Image size 2352x1568
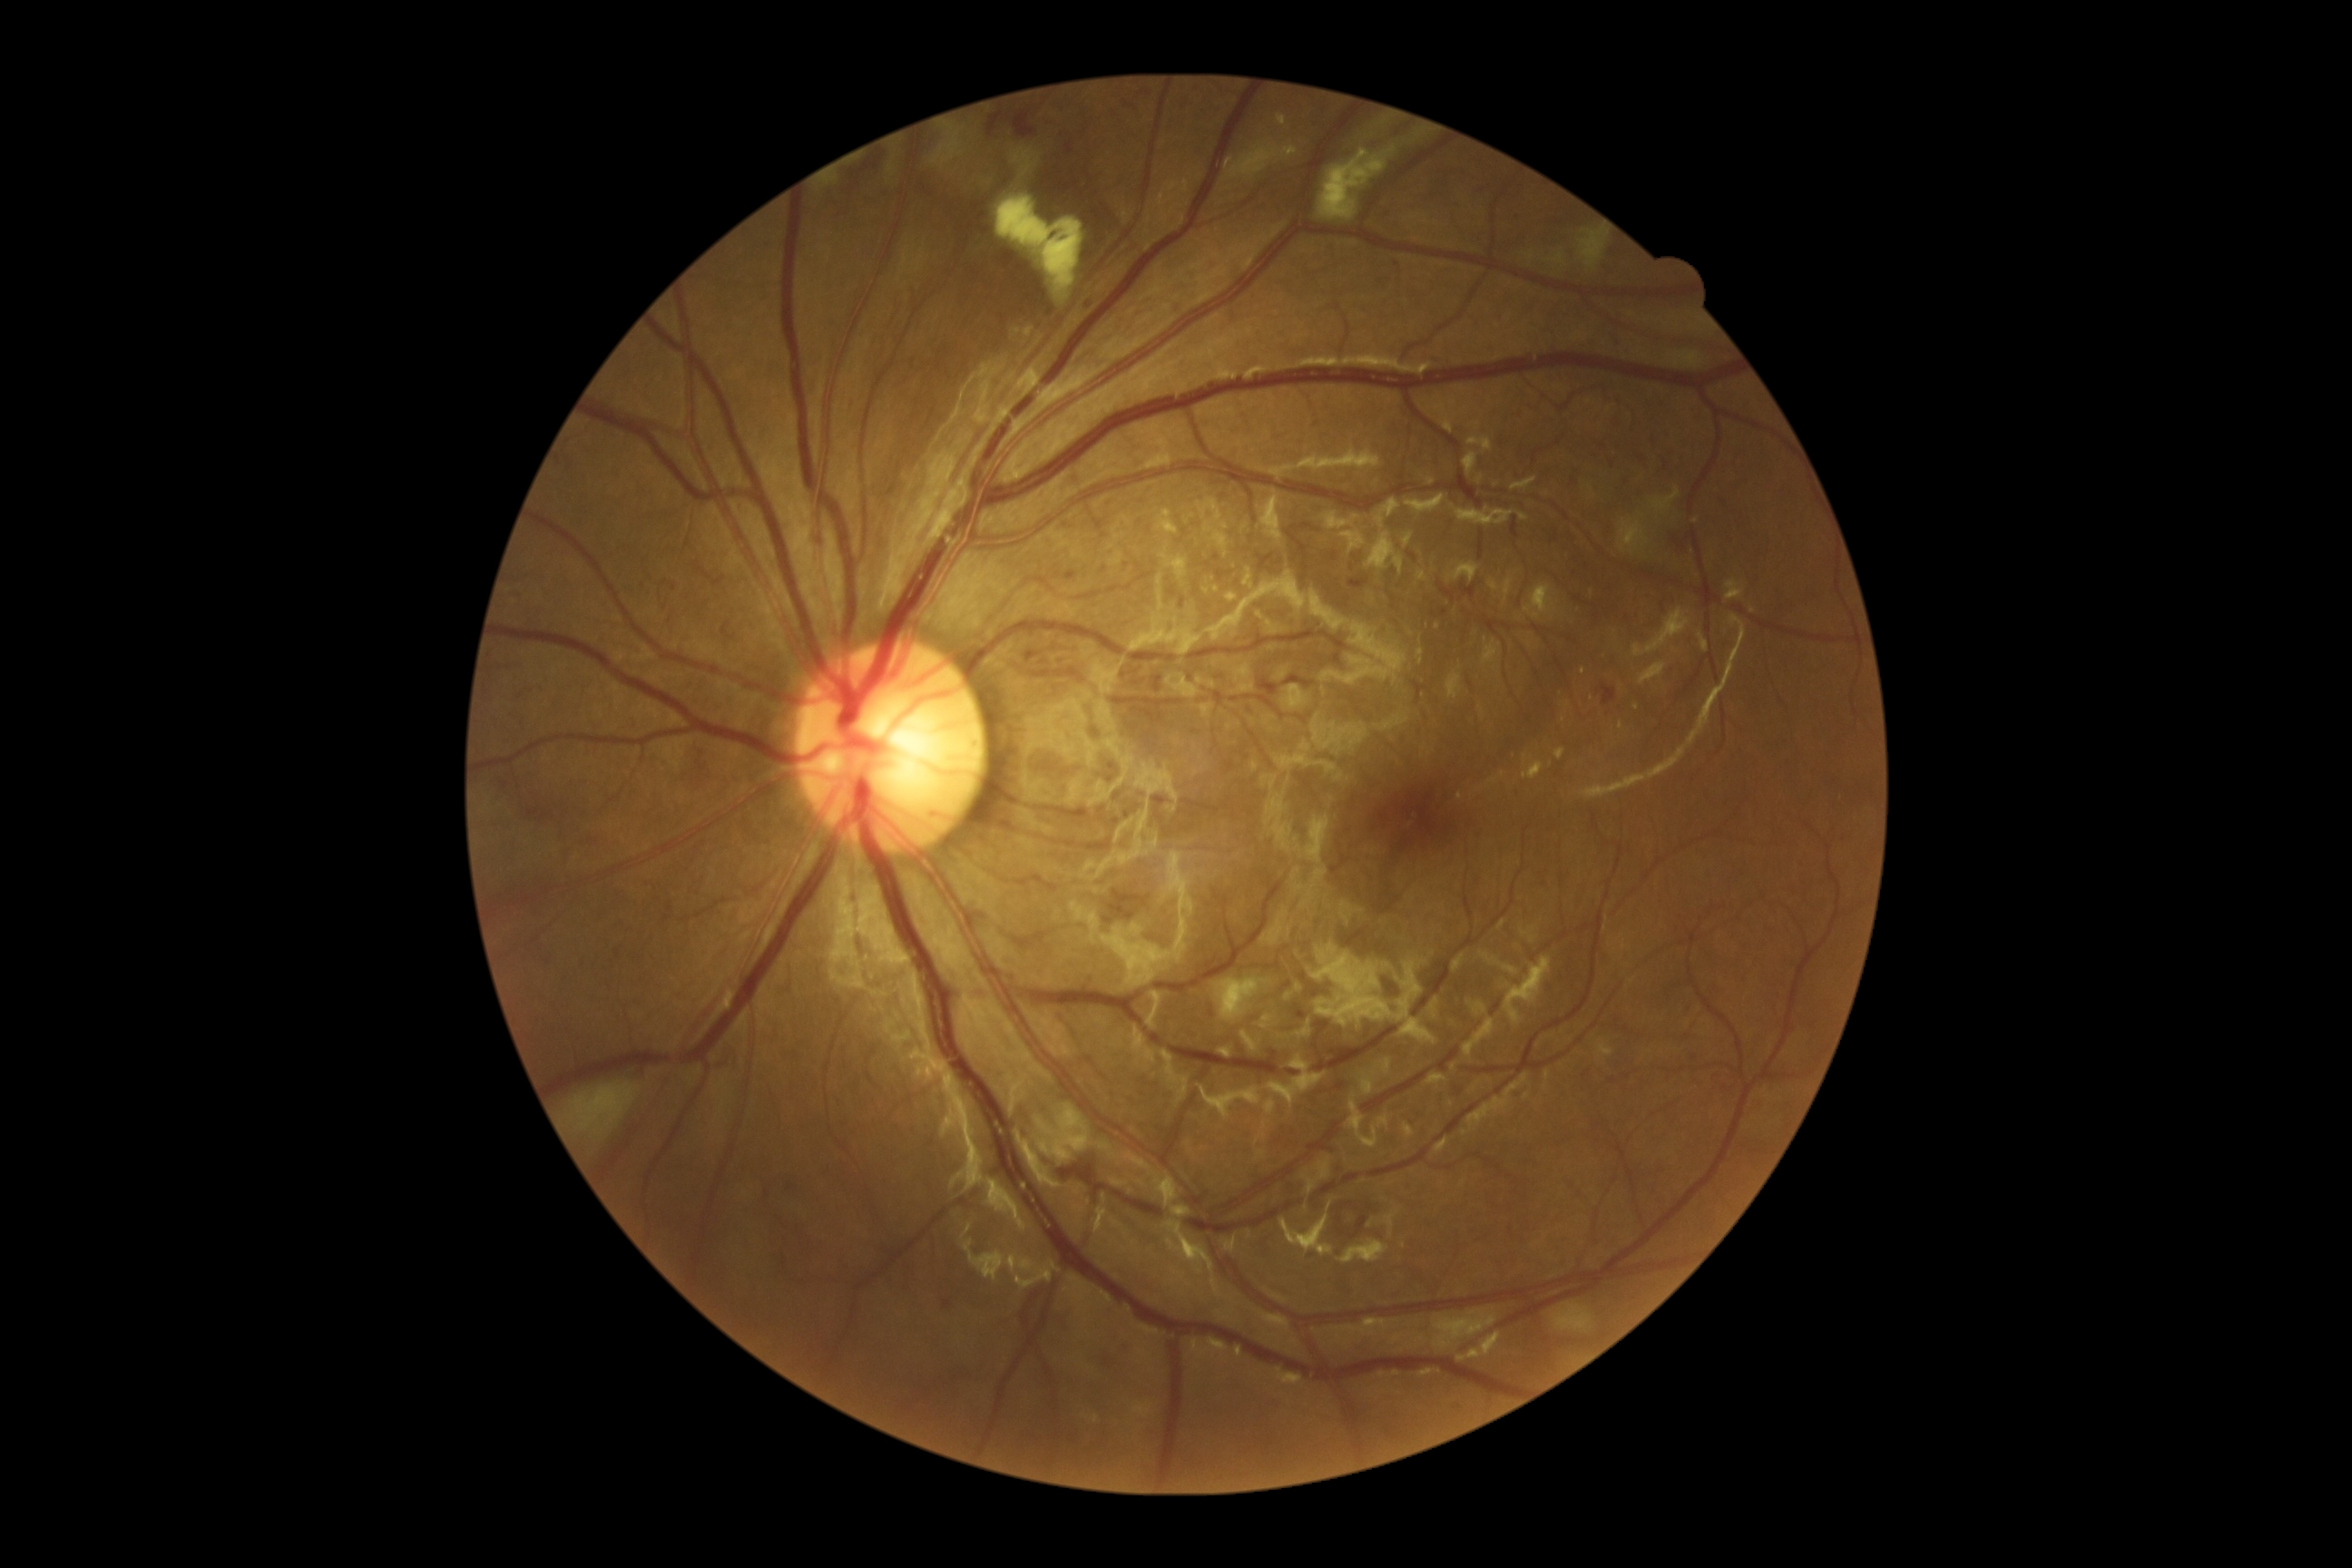

{"partial": true, "dr_grade": 2, "dr_grade_name": "moderate NPDR", "lesions": {"ex": [[1416, 649, 1424, 663], [1620, 721, 1623, 730], [1524, 754, 1529, 765], [1226, 593, 1239, 603], [1246, 571, 1251, 587], [1524, 761, 1545, 781]], "ex_small_centers": [[1562, 691], [1233, 567], [1460, 796], [1637, 707], [1238, 579]]}}